848 x 848 pixels, 45° FOV
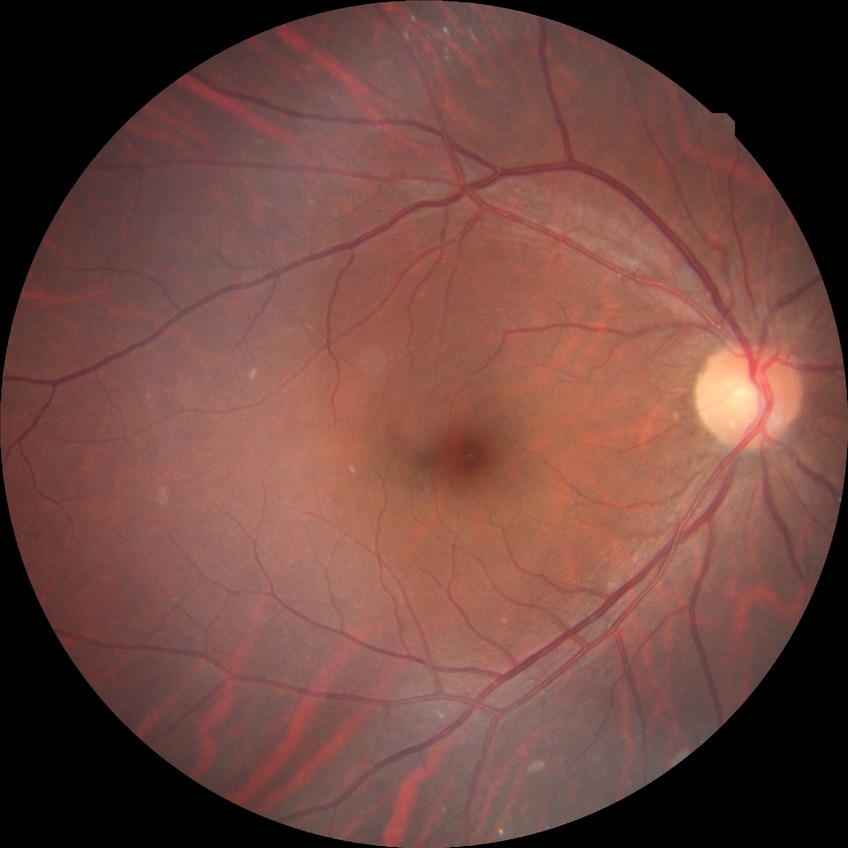

Assessment:
* Davis grading — no diabetic retinopathy